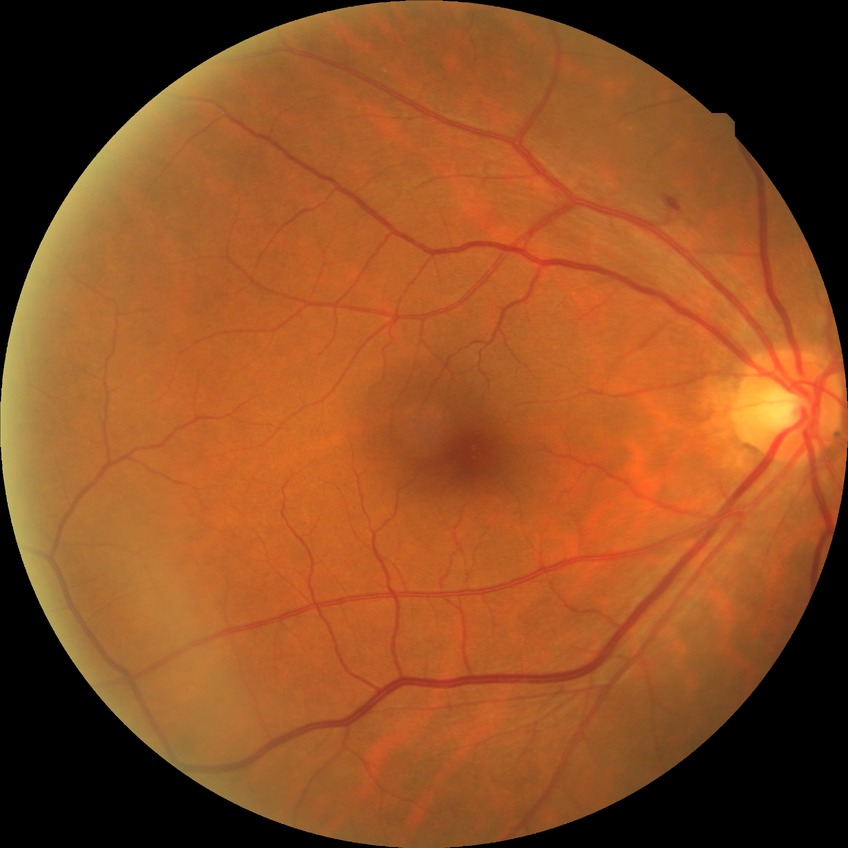
Diabetic retinopathy stage: no diabetic retinopathy.